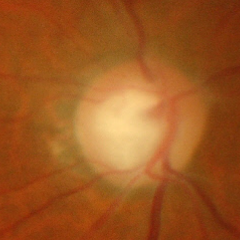 Fundus appearance consistent with early-stage glaucoma.